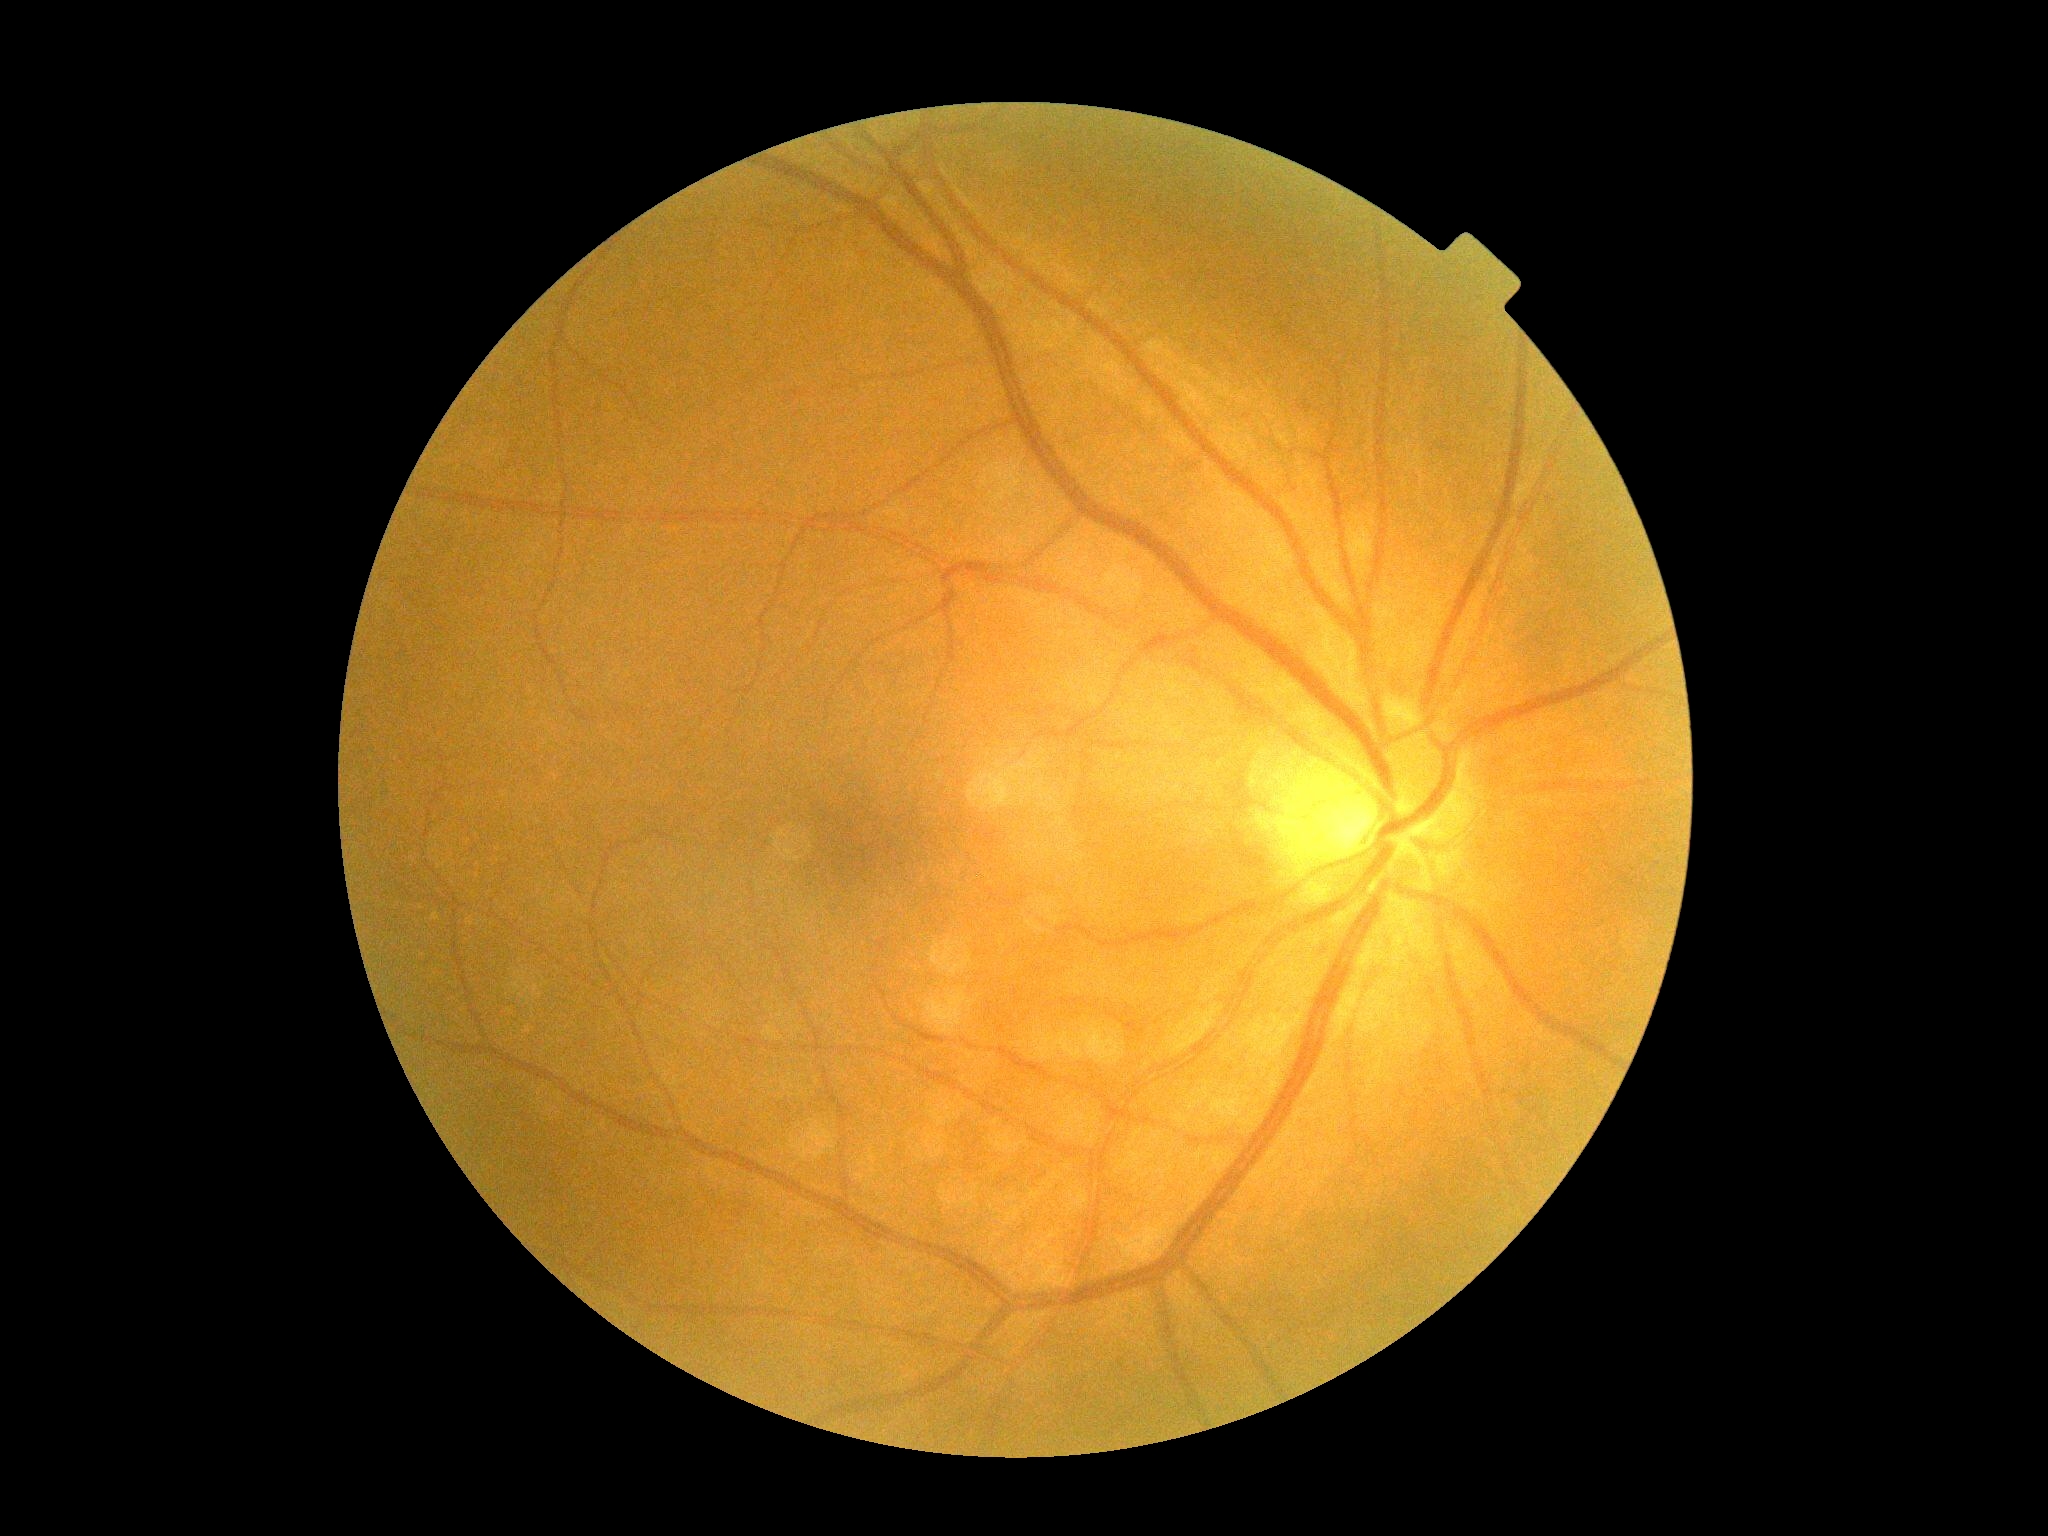 DR impression: no signs of DR; DR severity: no apparent retinopathy (grade 0) — no visible signs of diabetic retinopathy.